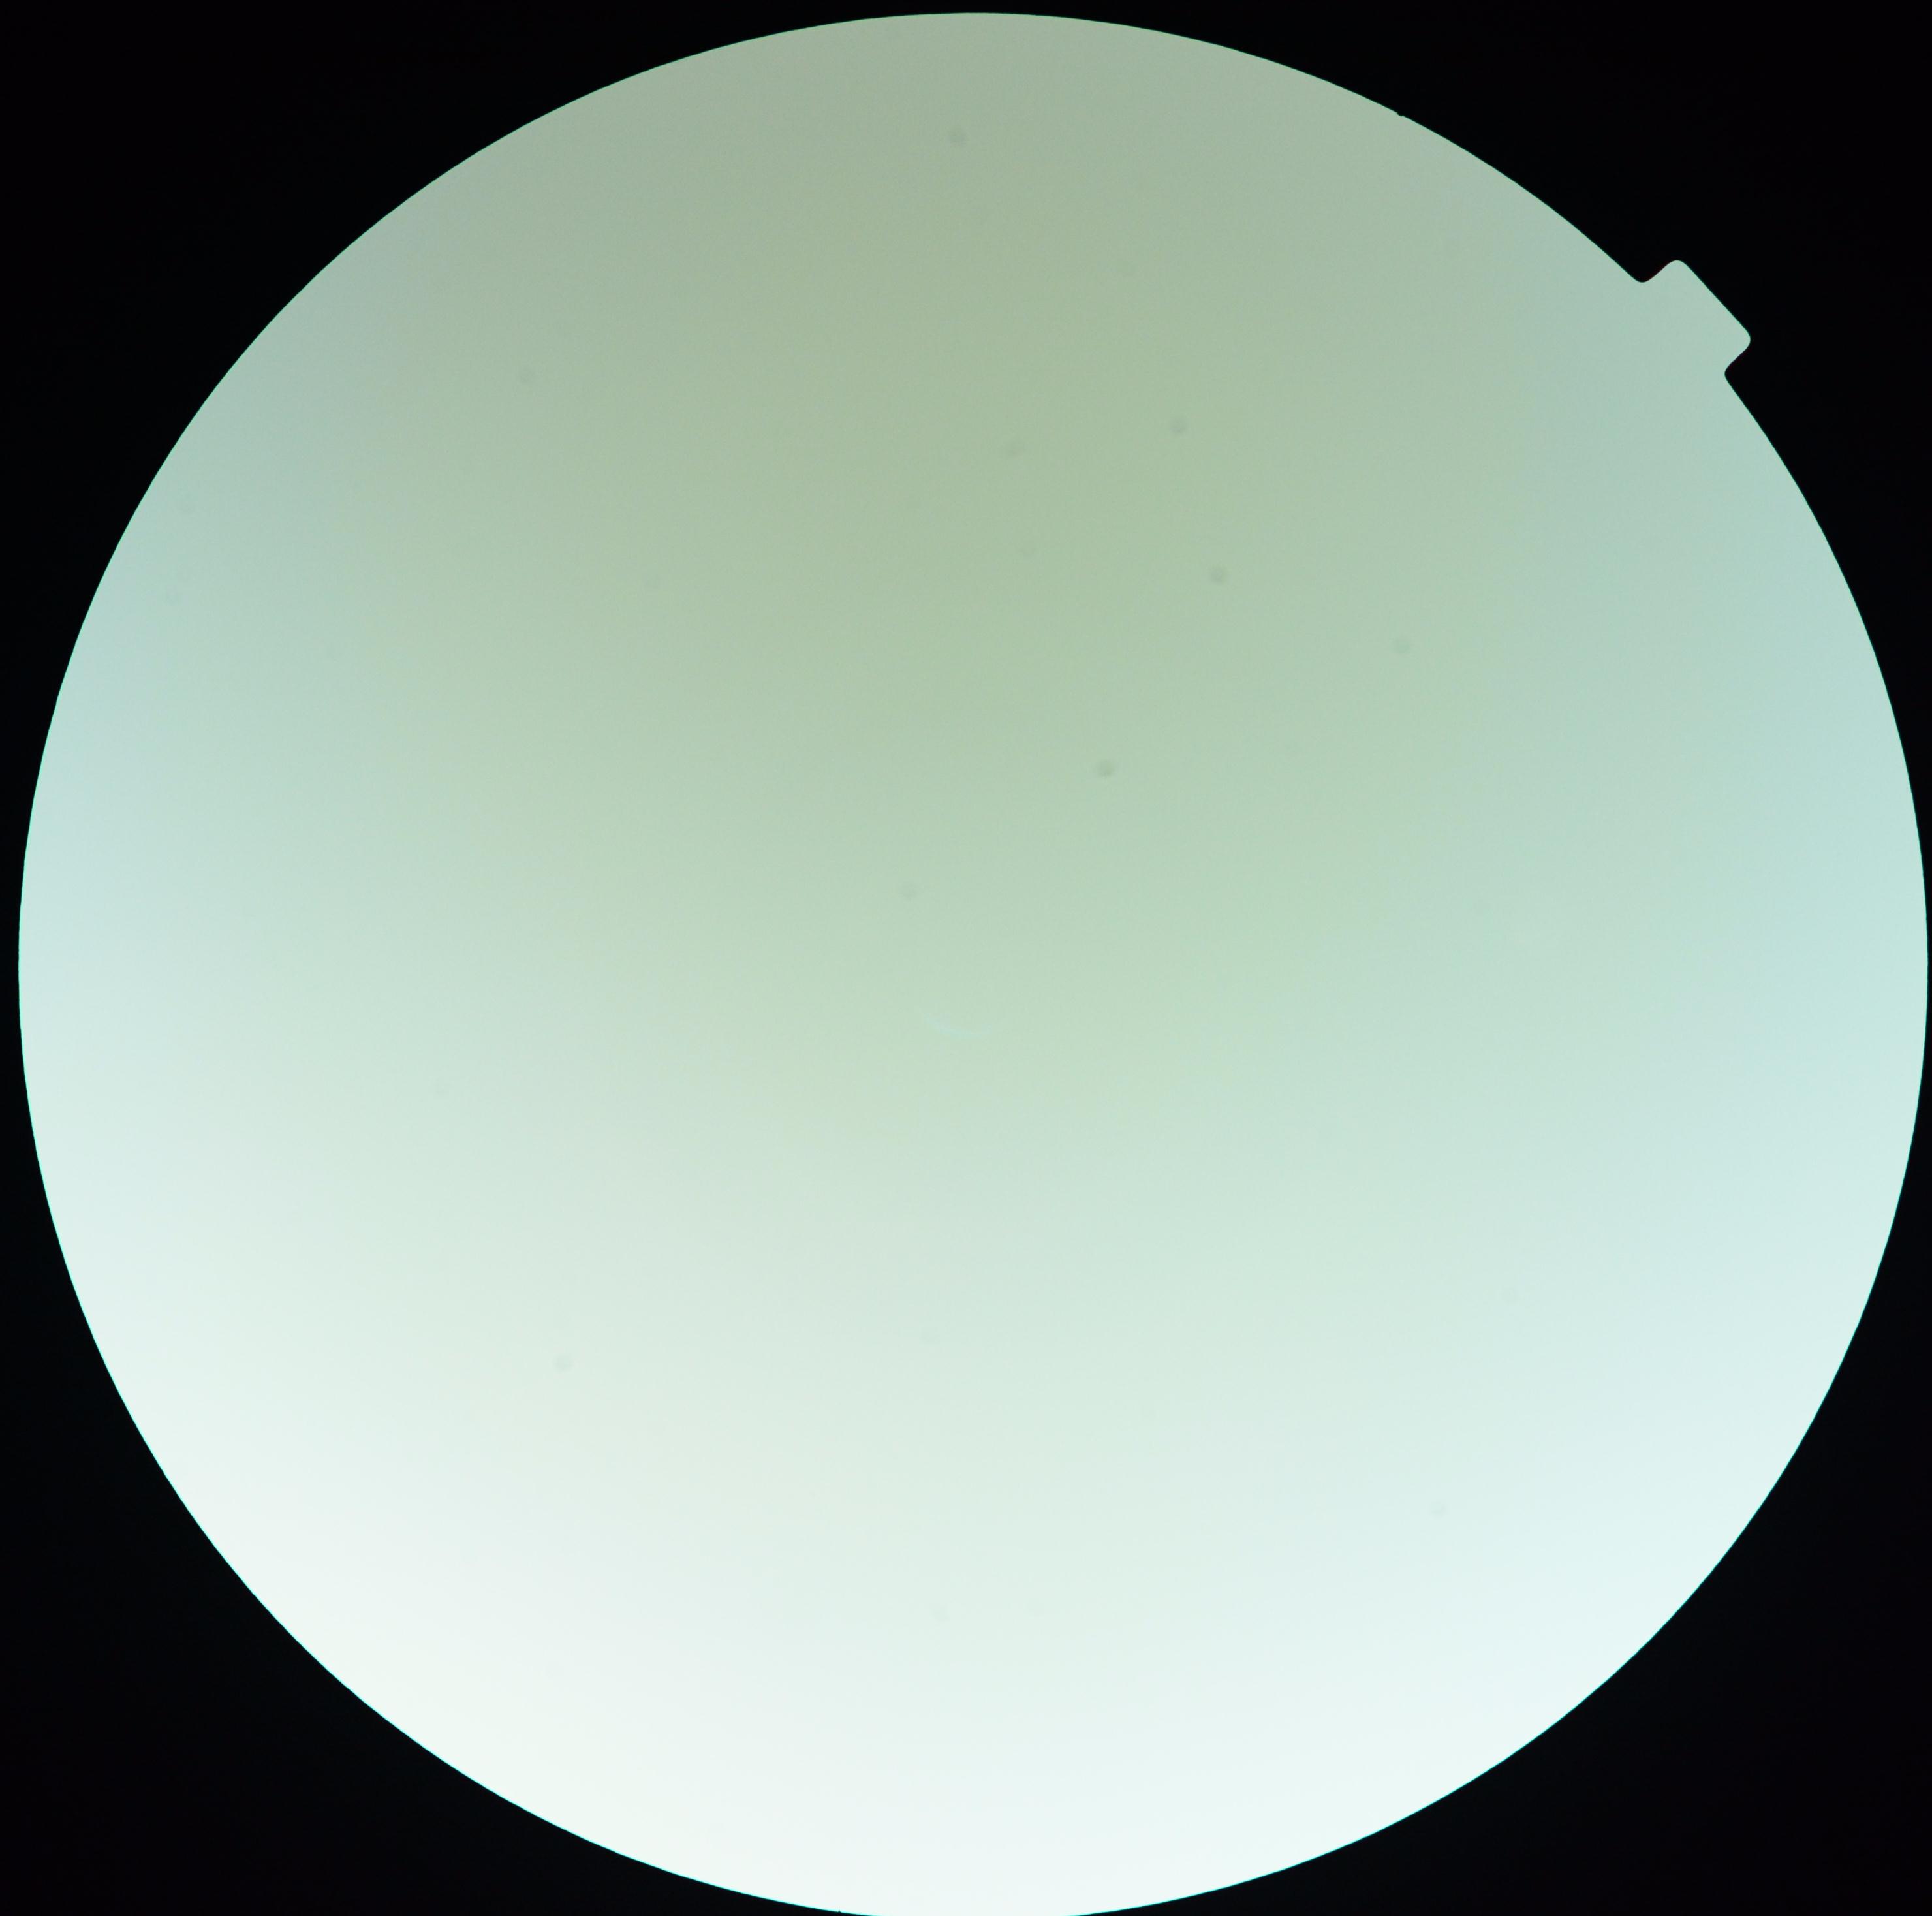
  dr_grade: ungradable due to poor image quality
  quality: insufficient